Wide-field fundus photograph from neonatal ROP screening: 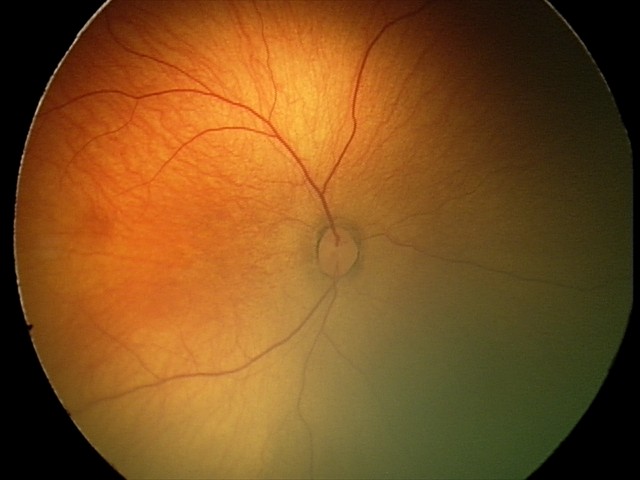
Screening examination diagnosed as physiological.